Captured with the Clarity RetCam 3 (130° field of view) · 640 x 480 pixels · RetCam wide-field infant fundus image.
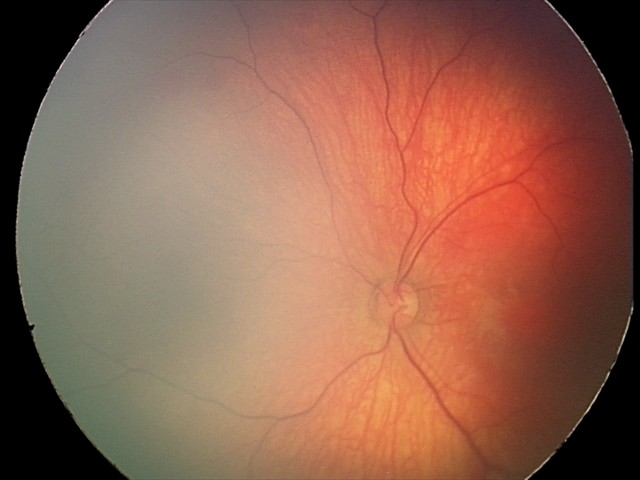
Series diagnosed as retinal hemorrhages.